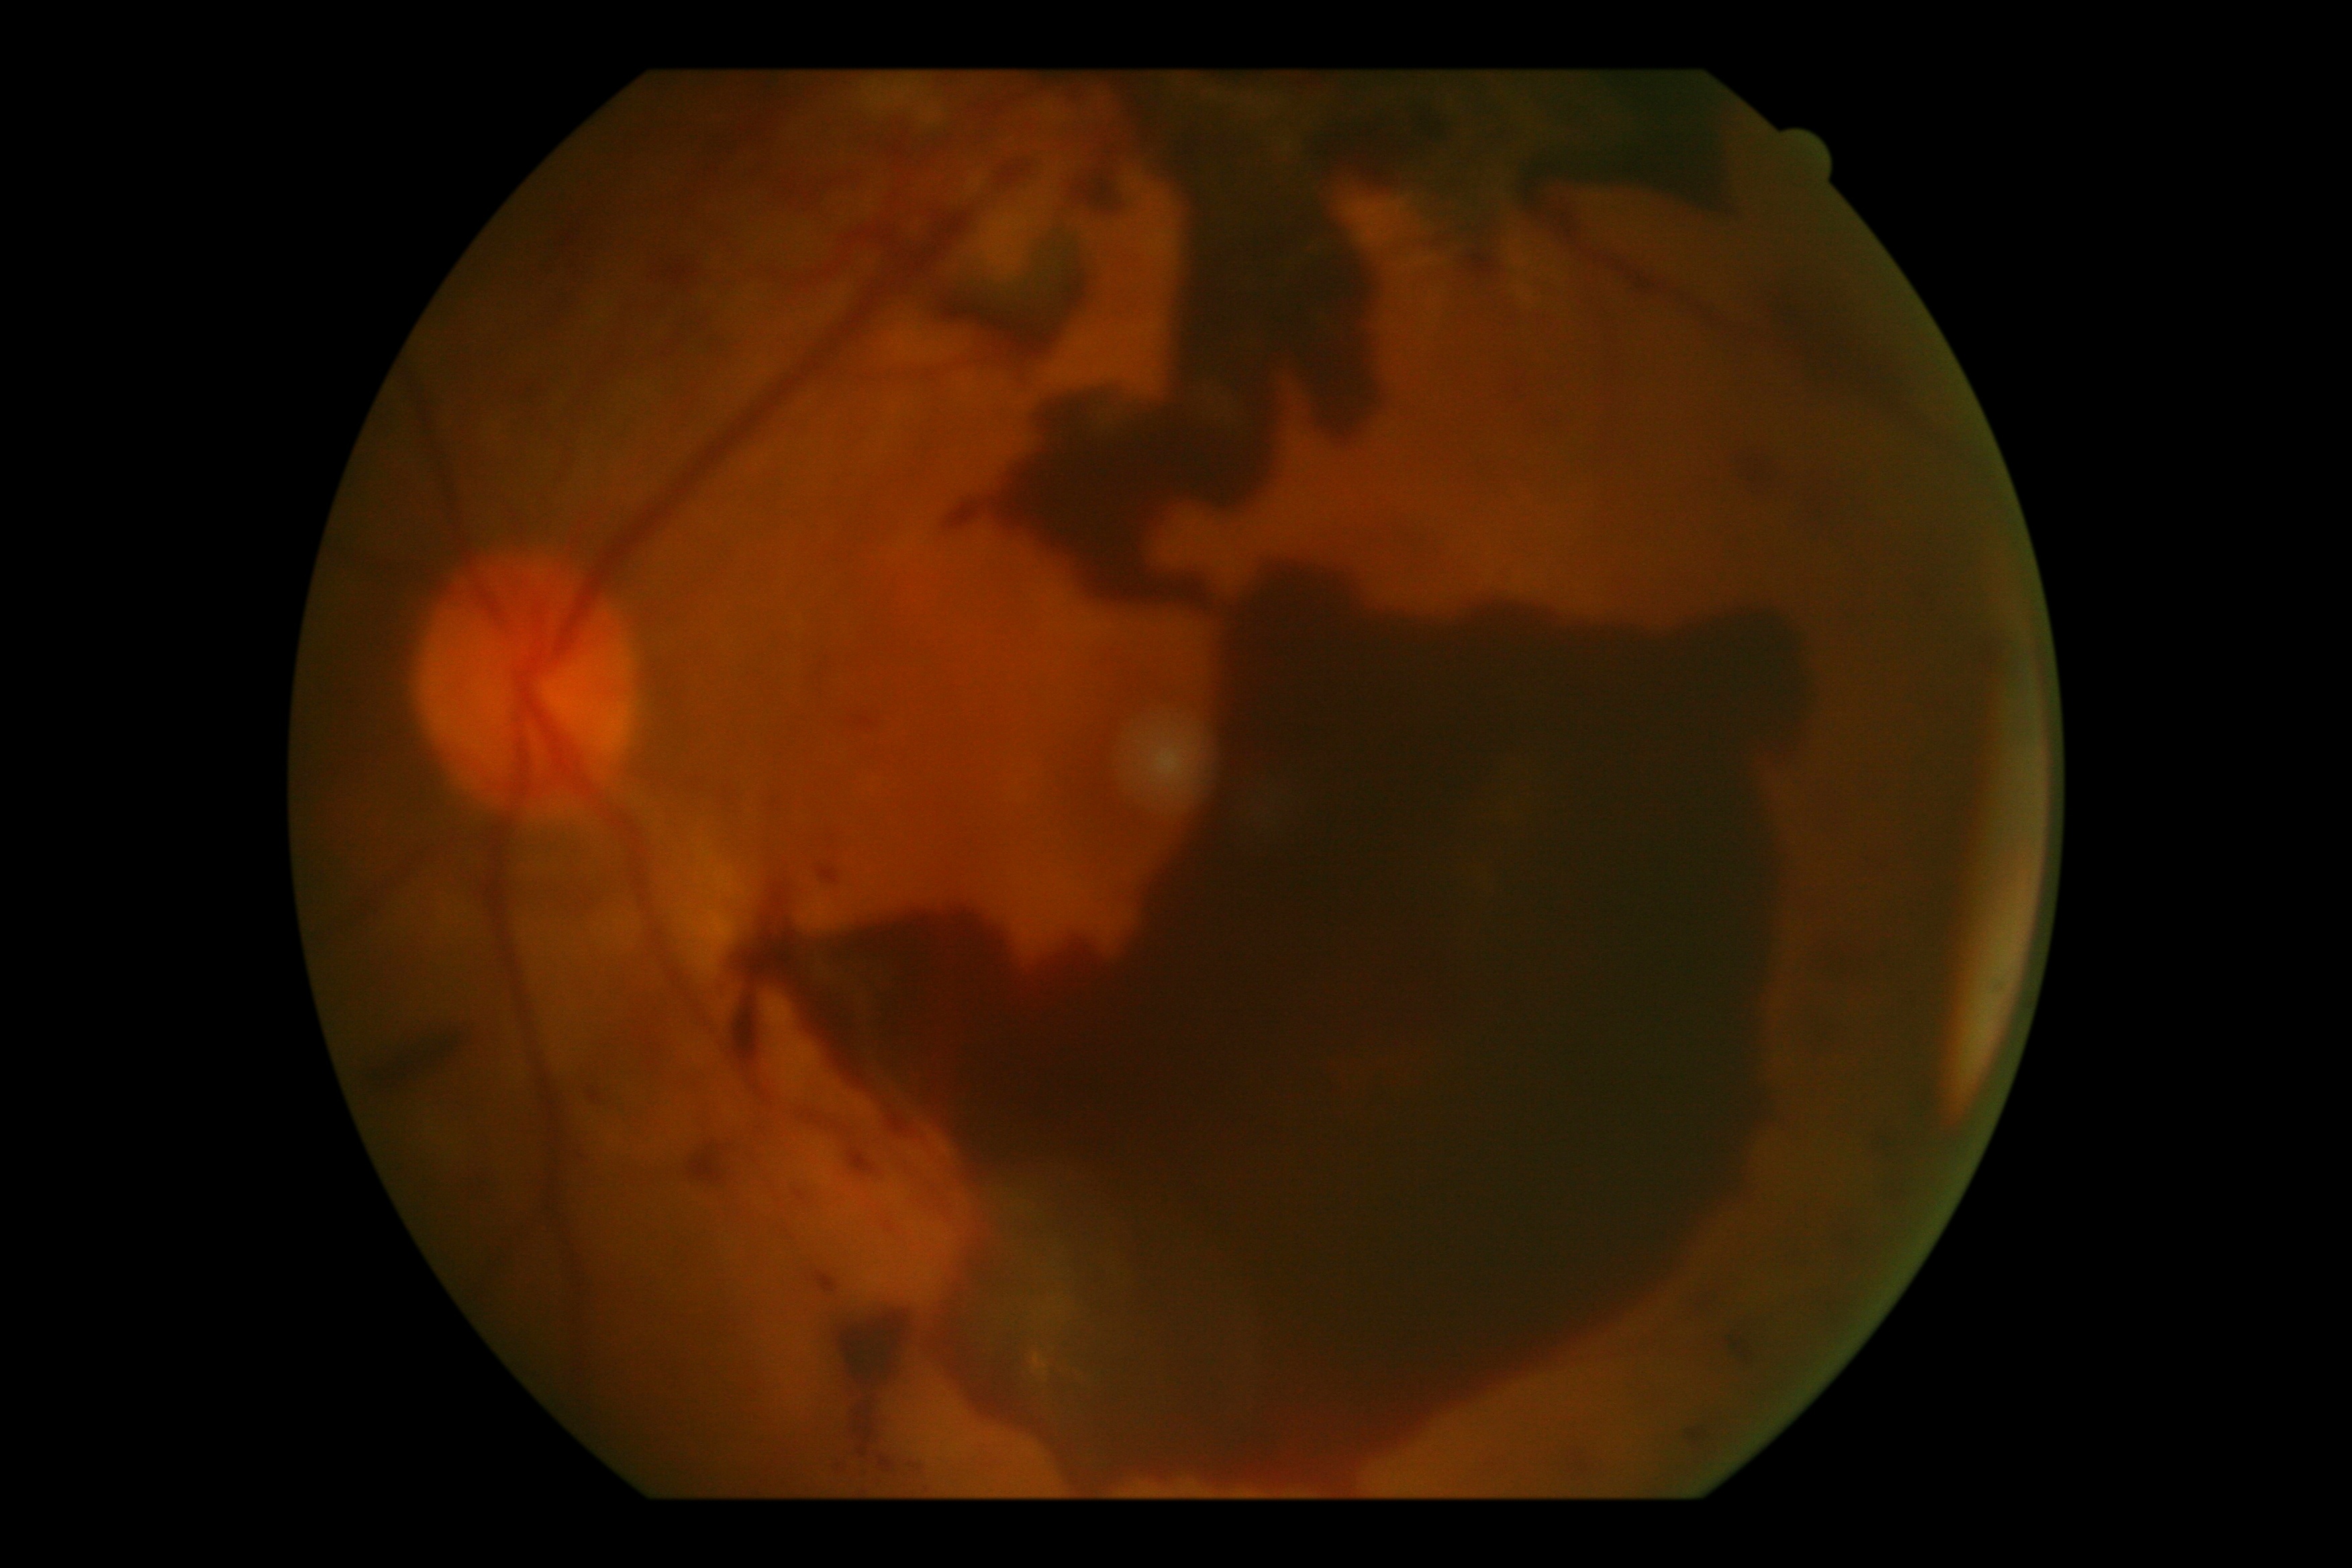

DR severity: 4.